1659 by 2212 pixels. Acquired with a Remidio FOP fundus camera. Color fundus photograph: 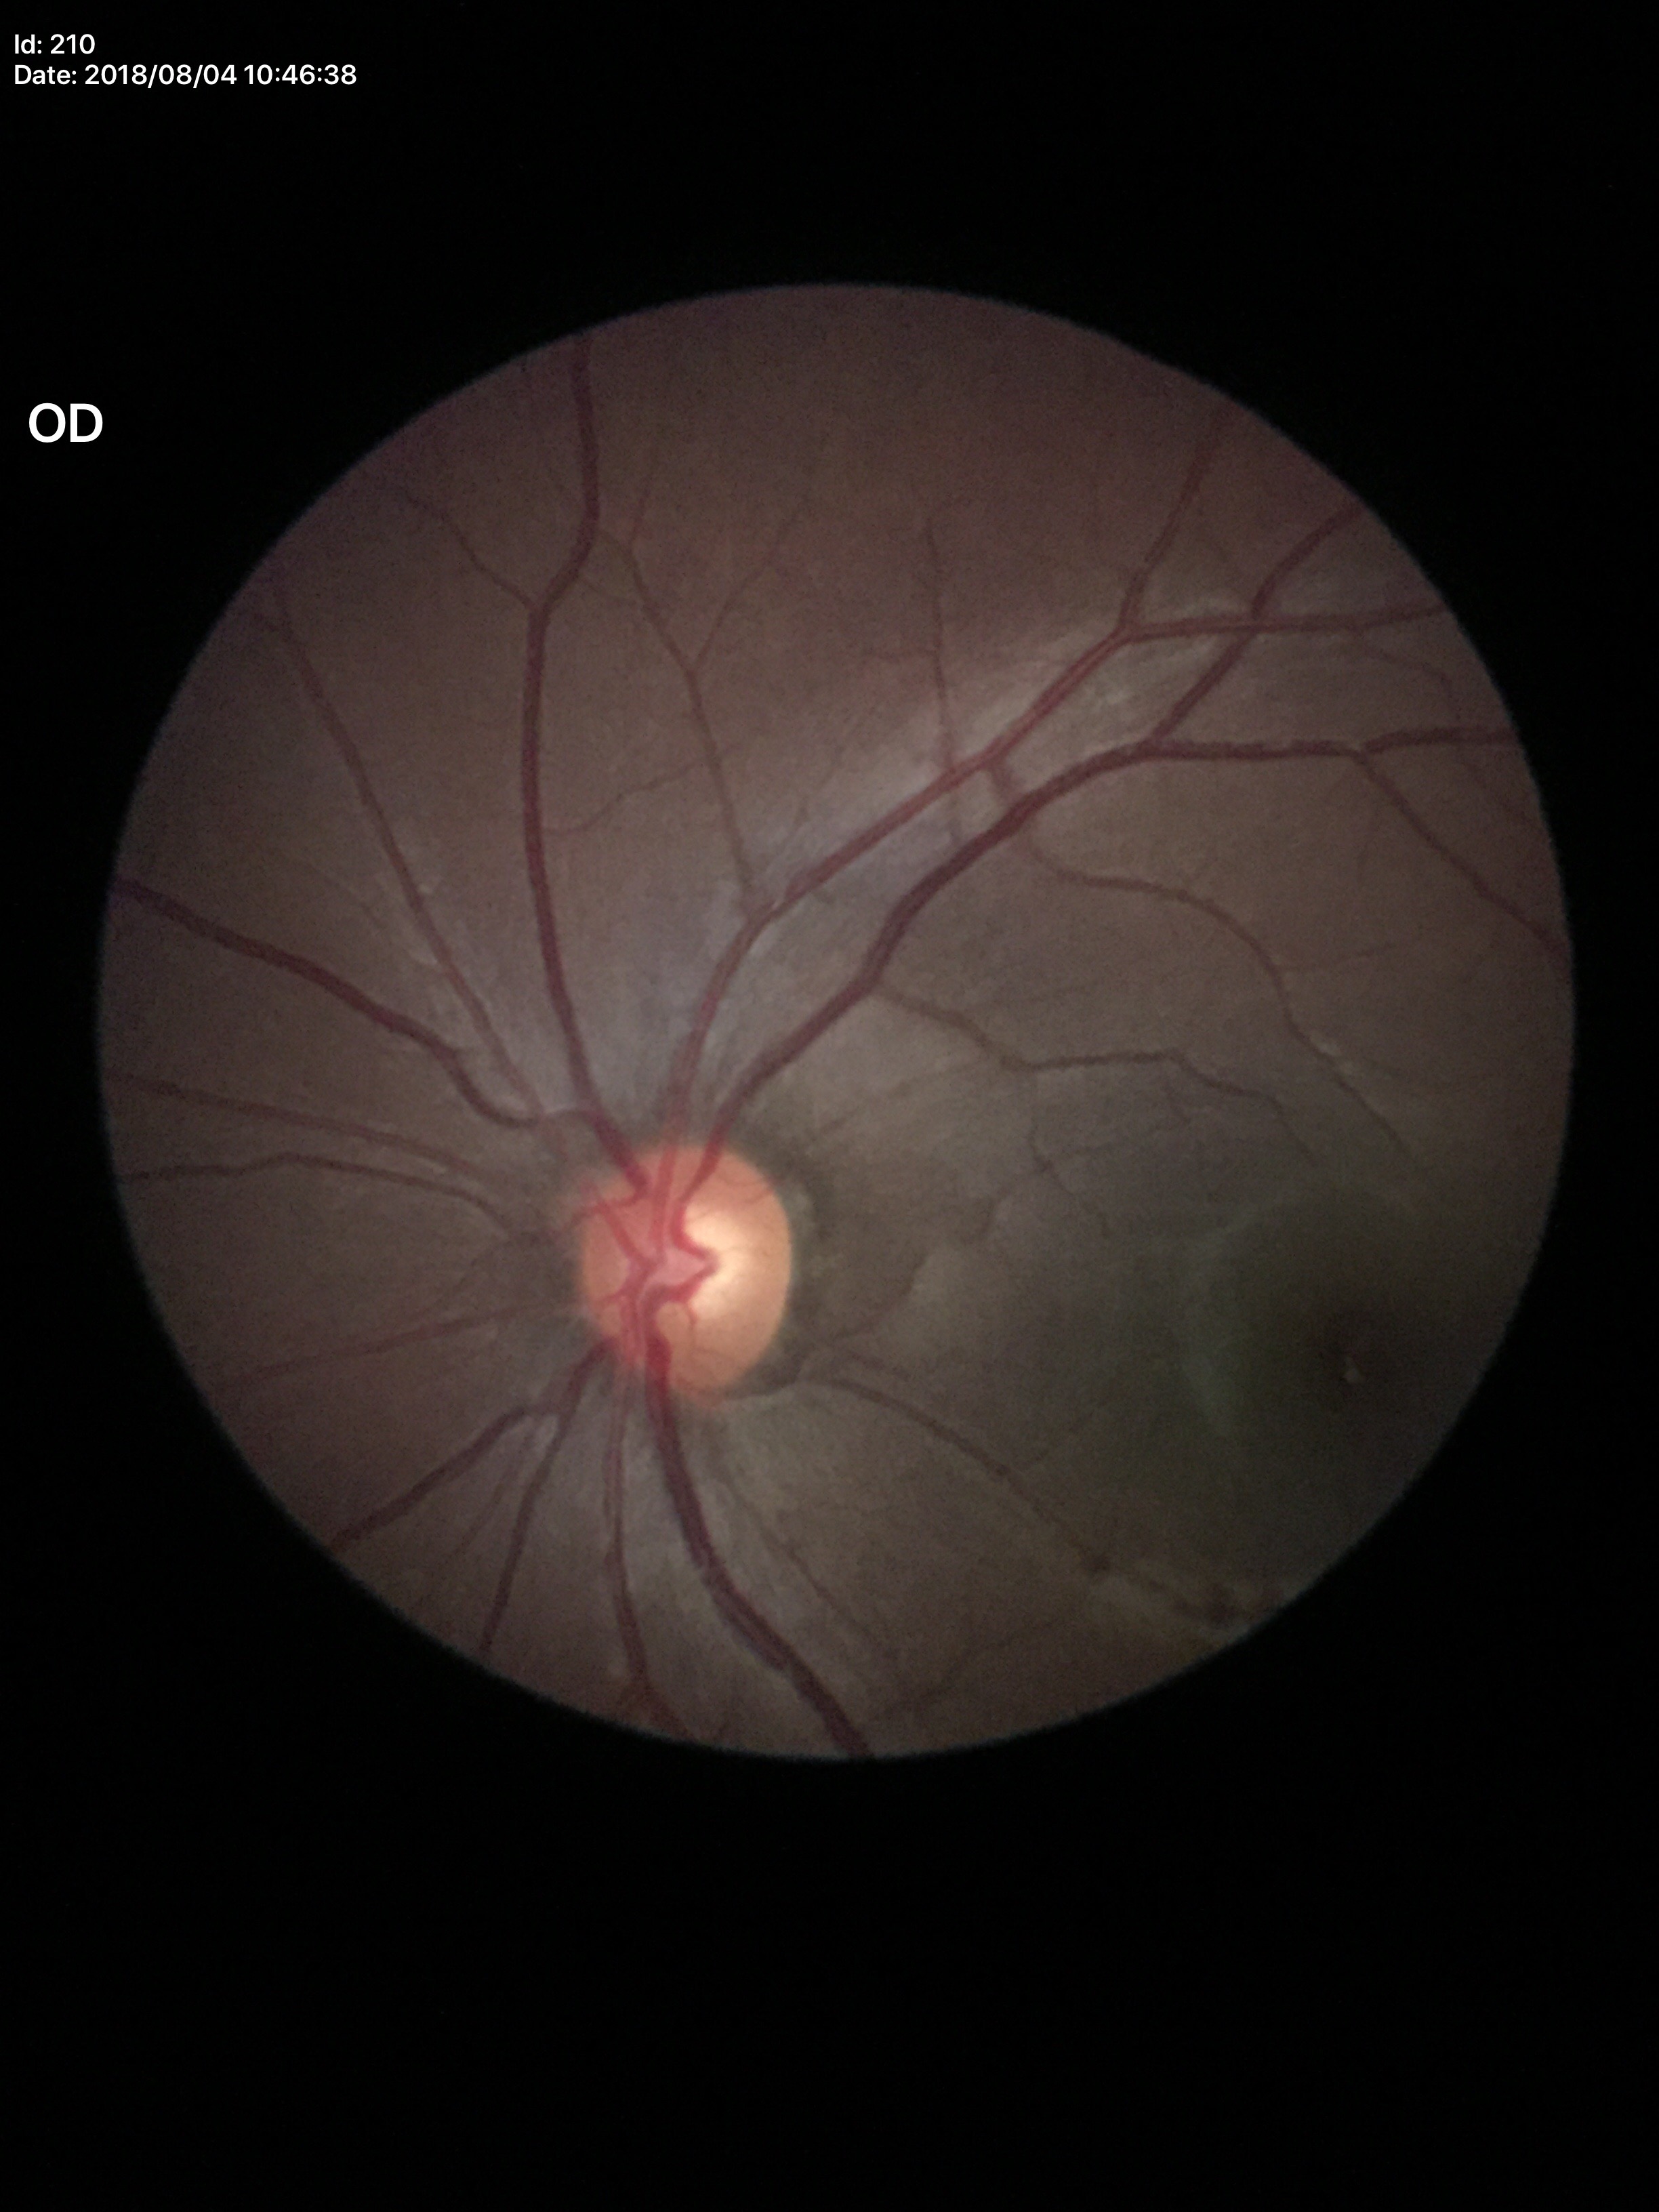
Vertical C/D ratio: 0.53. Glaucoma impression: negative.